Image size 1924x1556, ultra-widefield (UWF) fundus image — 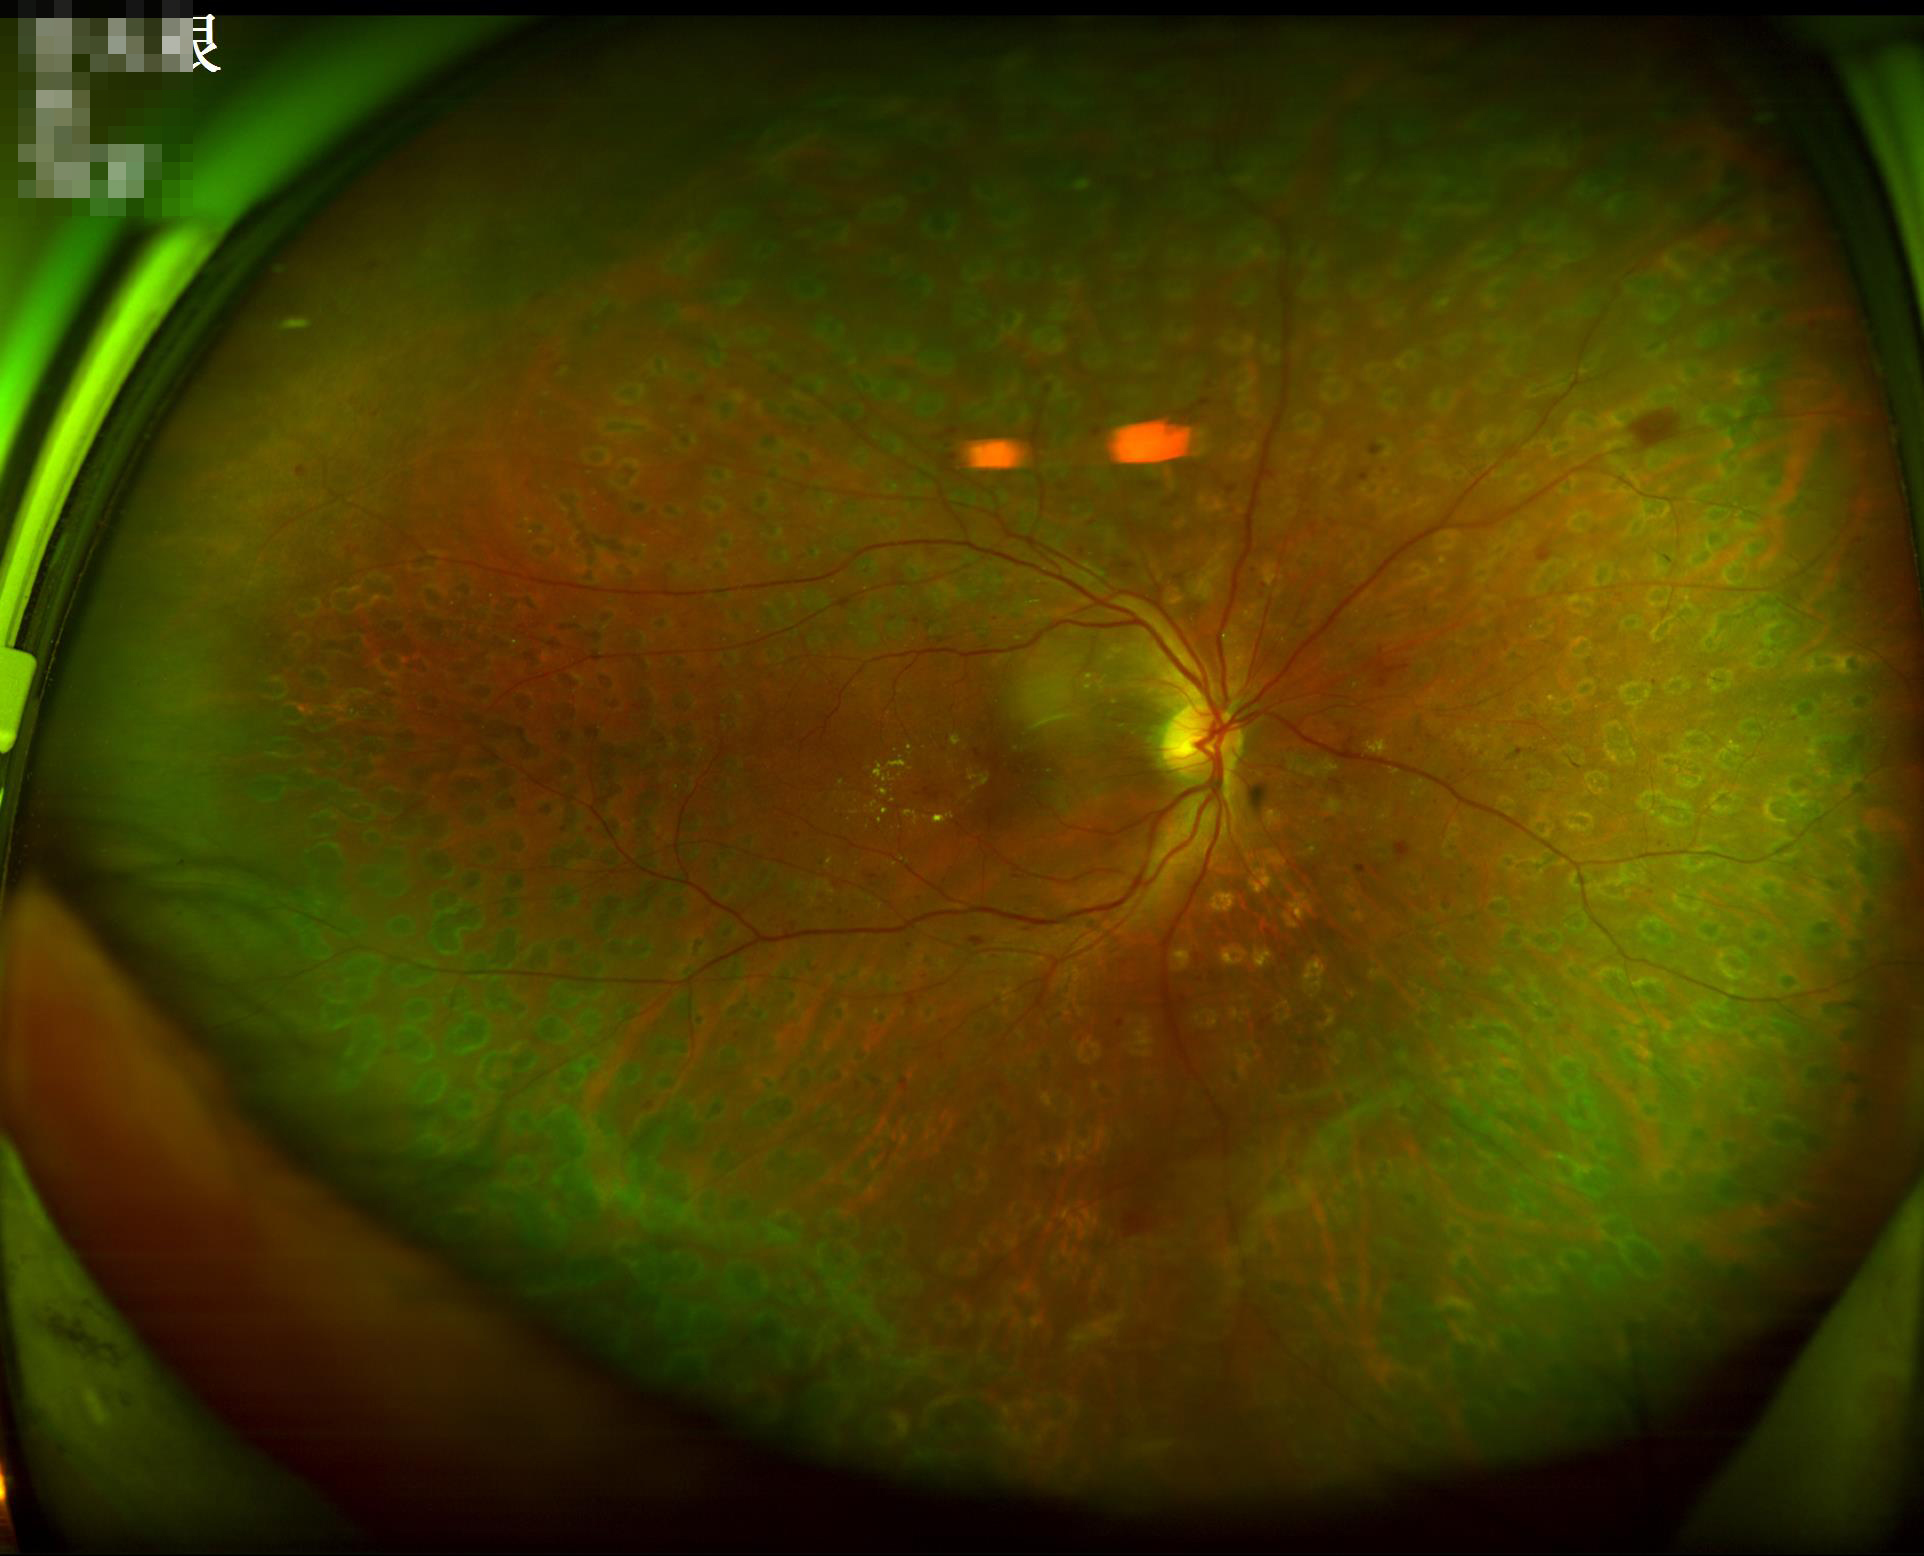

Acceptable image quality. Even illumination with no color cast. Contrast is good.